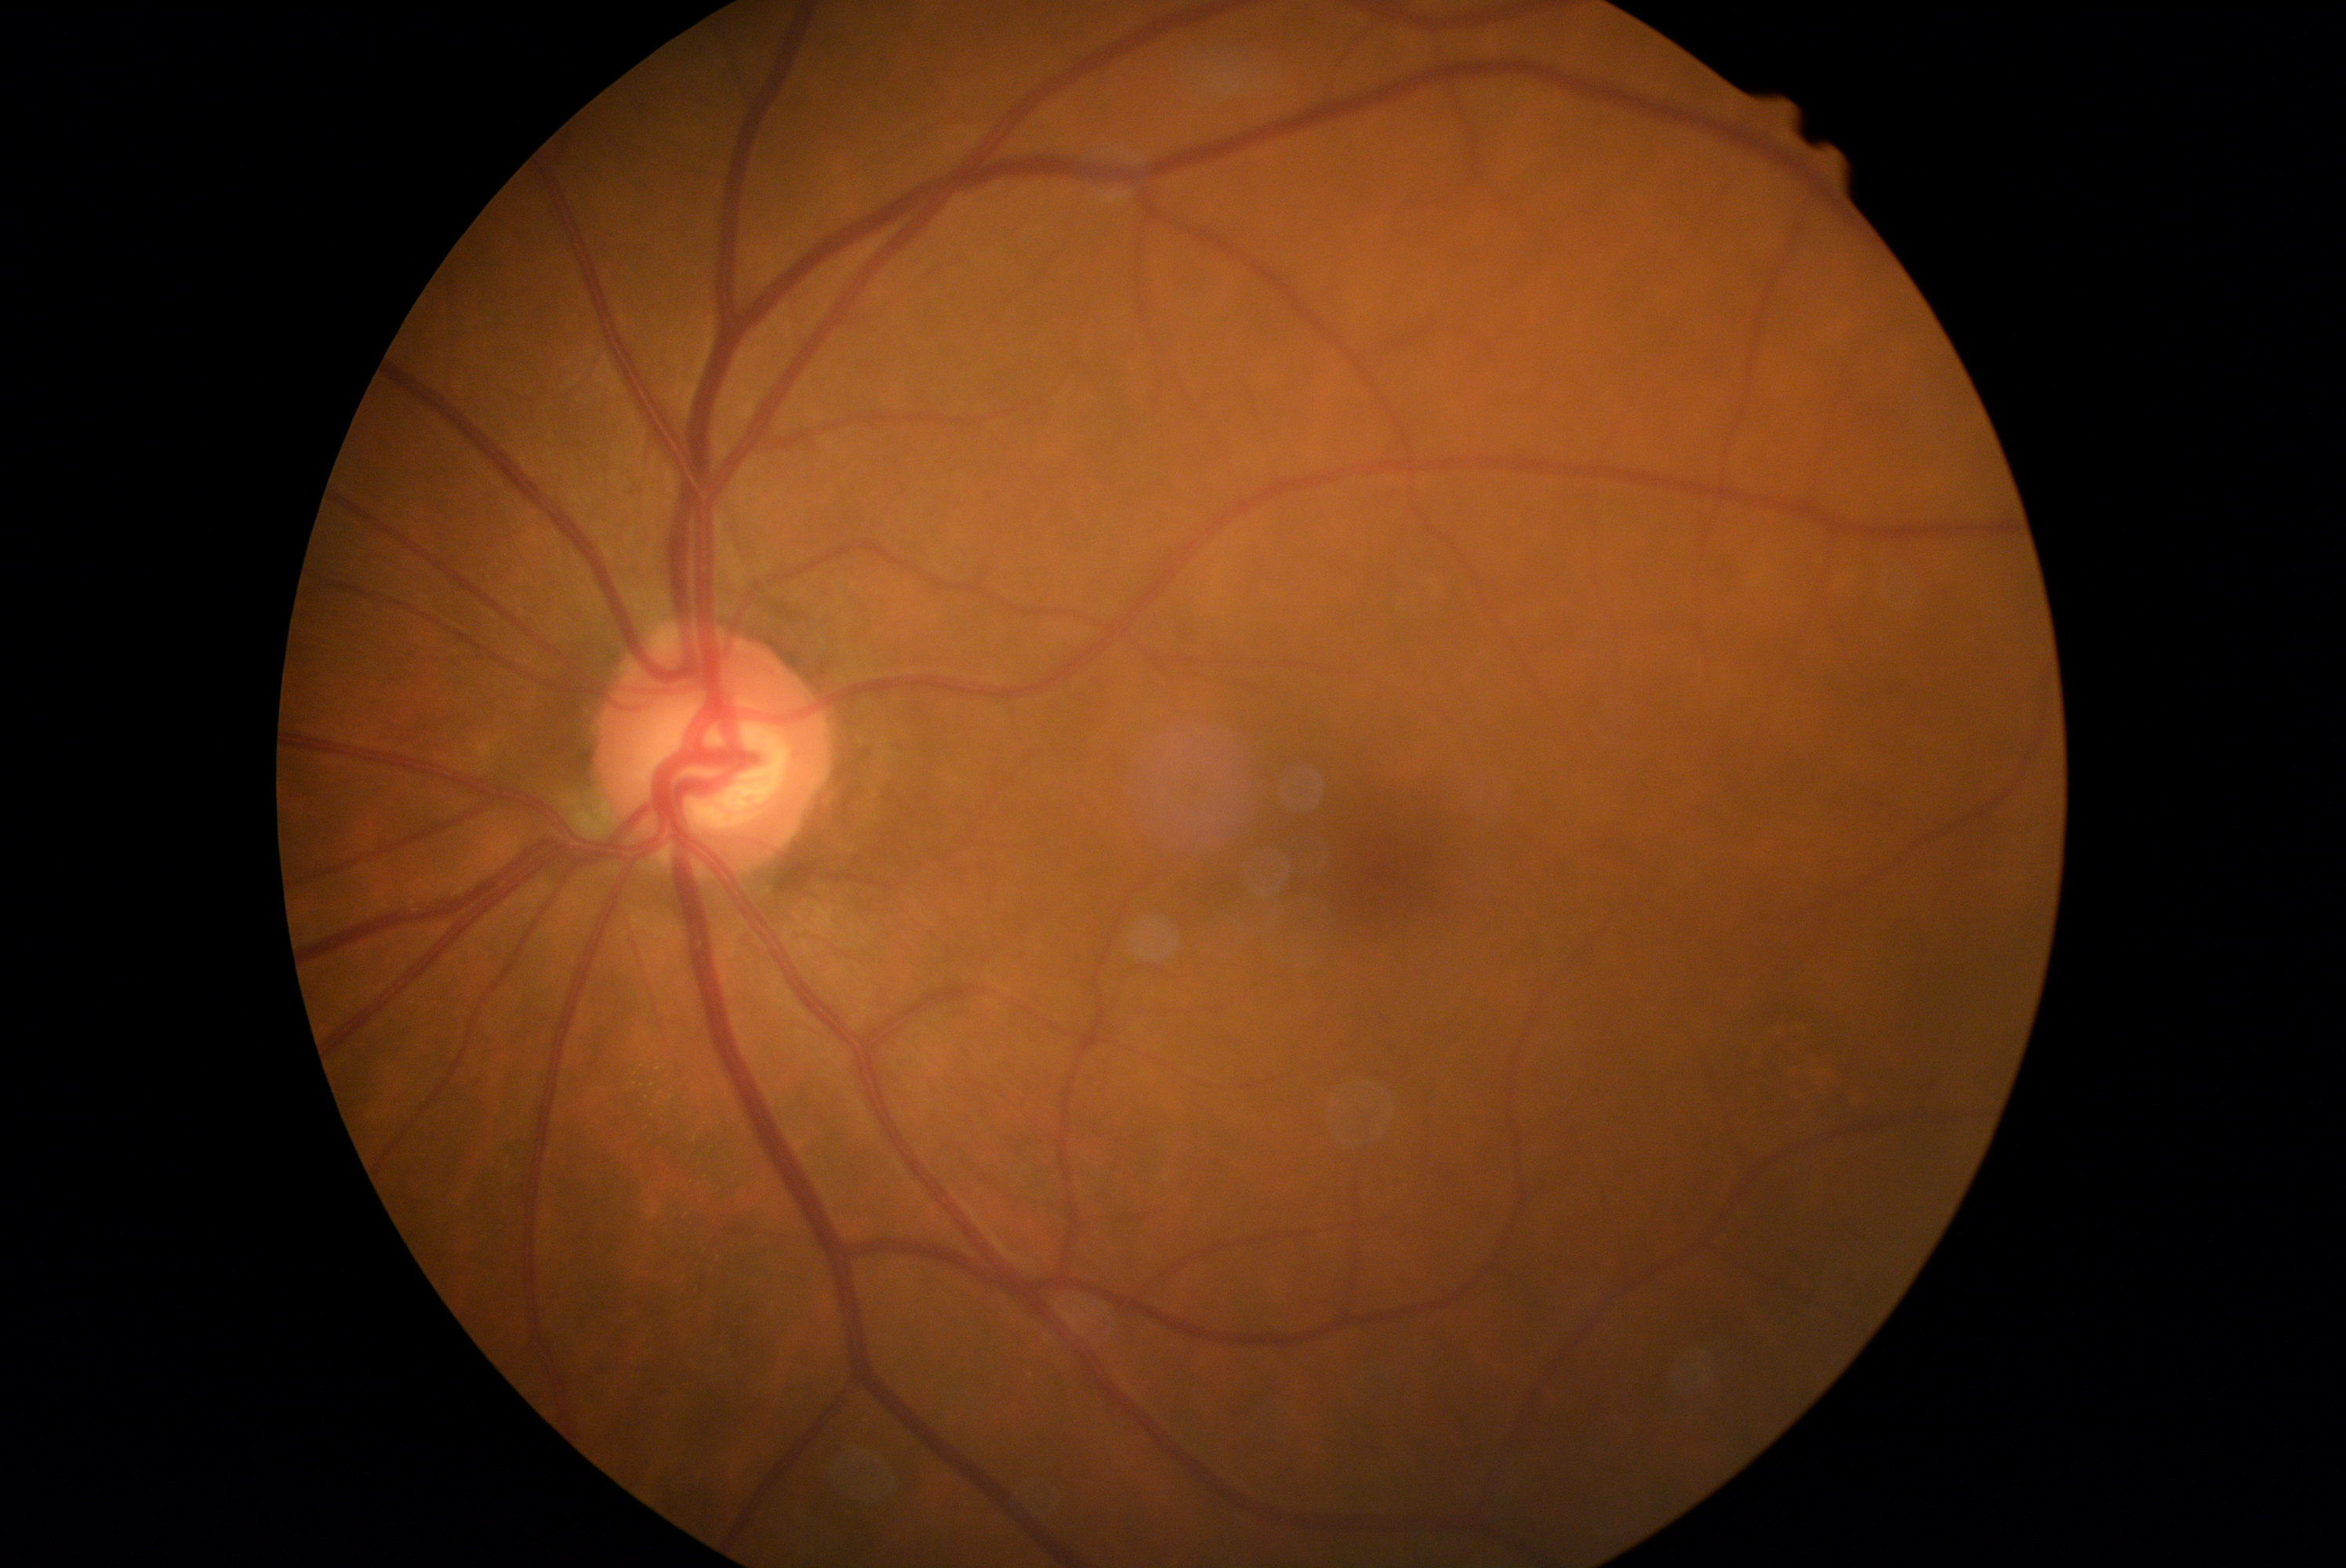
• DR severity — 0
• DR impression — no DR findings